Retinal fundus photograph:
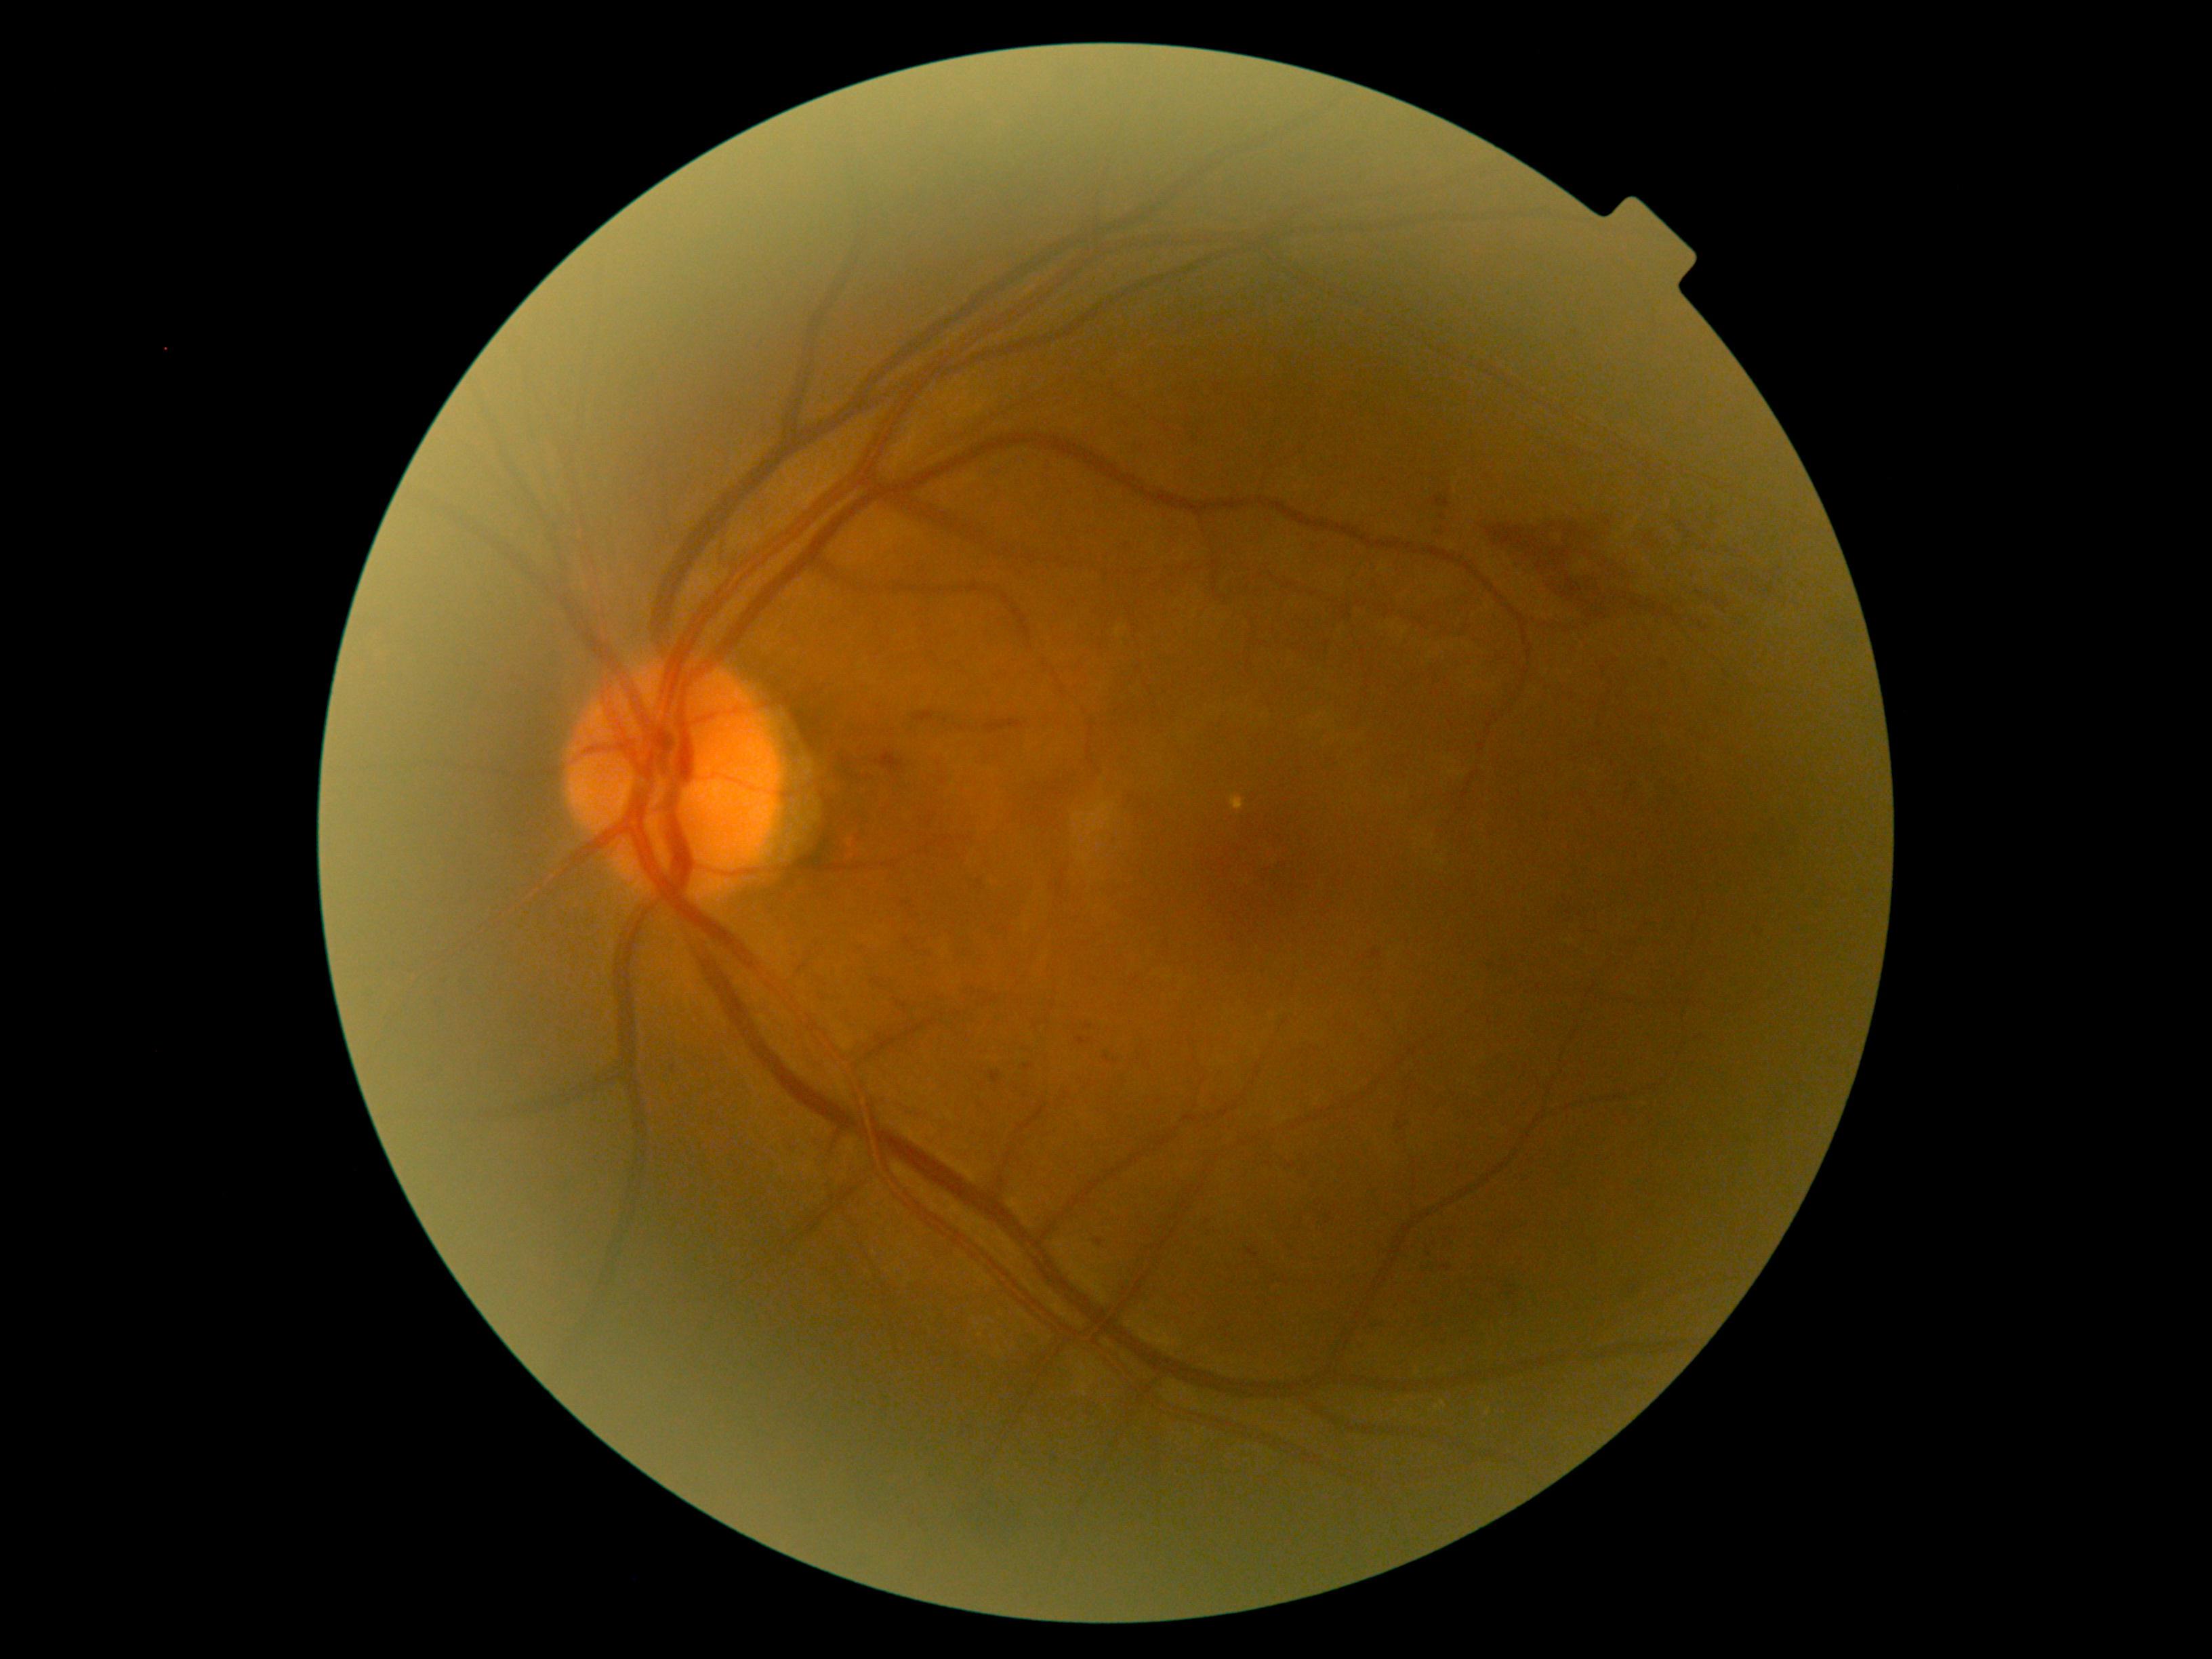
partial: true
dr_grade: 2
lesions:
  he:
    - {"left": 1359, "top": 1317, "right": 1385, "bottom": 1337}
    - {"left": 1431, "top": 495, "right": 1451, "bottom": 509}
    - {"left": 869, "top": 745, "right": 910, "bottom": 779}
    - {"left": 1497, "top": 1284, "right": 1527, "bottom": 1309}
    - {"left": 1326, "top": 1214, "right": 1332, "bottom": 1225}
    - {"left": 1024, "top": 1065, "right": 1033, "bottom": 1071}
    - {"left": 990, "top": 1070, "right": 1002, "bottom": 1084}
    - {"left": 897, "top": 1002, "right": 907, "bottom": 1013}
    - {"left": 1561, "top": 448, "right": 1568, "bottom": 456}
    - {"left": 955, "top": 724, "right": 968, "bottom": 733}
    - {"left": 1096, "top": 1238, "right": 1104, "bottom": 1246}
    - {"left": 1104, "top": 1055, "right": 1119, "bottom": 1065}
  he_small_approx:
    - {"x": 1088, "y": 1027}
    - {"x": 1270, "y": 1165}
    - {"x": 1160, "y": 1102}
    - {"x": 674, "y": 1068}